NIDEK AFC-230 fundus camera. CFP. 45 degree fundus photograph. No pharmacologic dilation
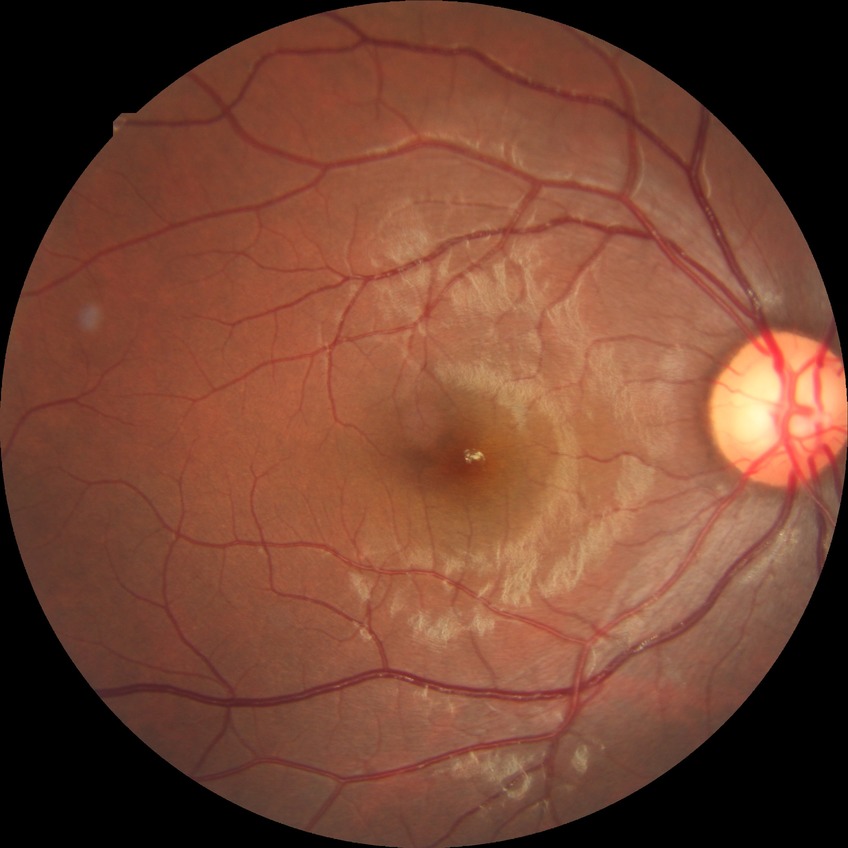
Diabetic retinopathy grade: no diabetic retinopathy.